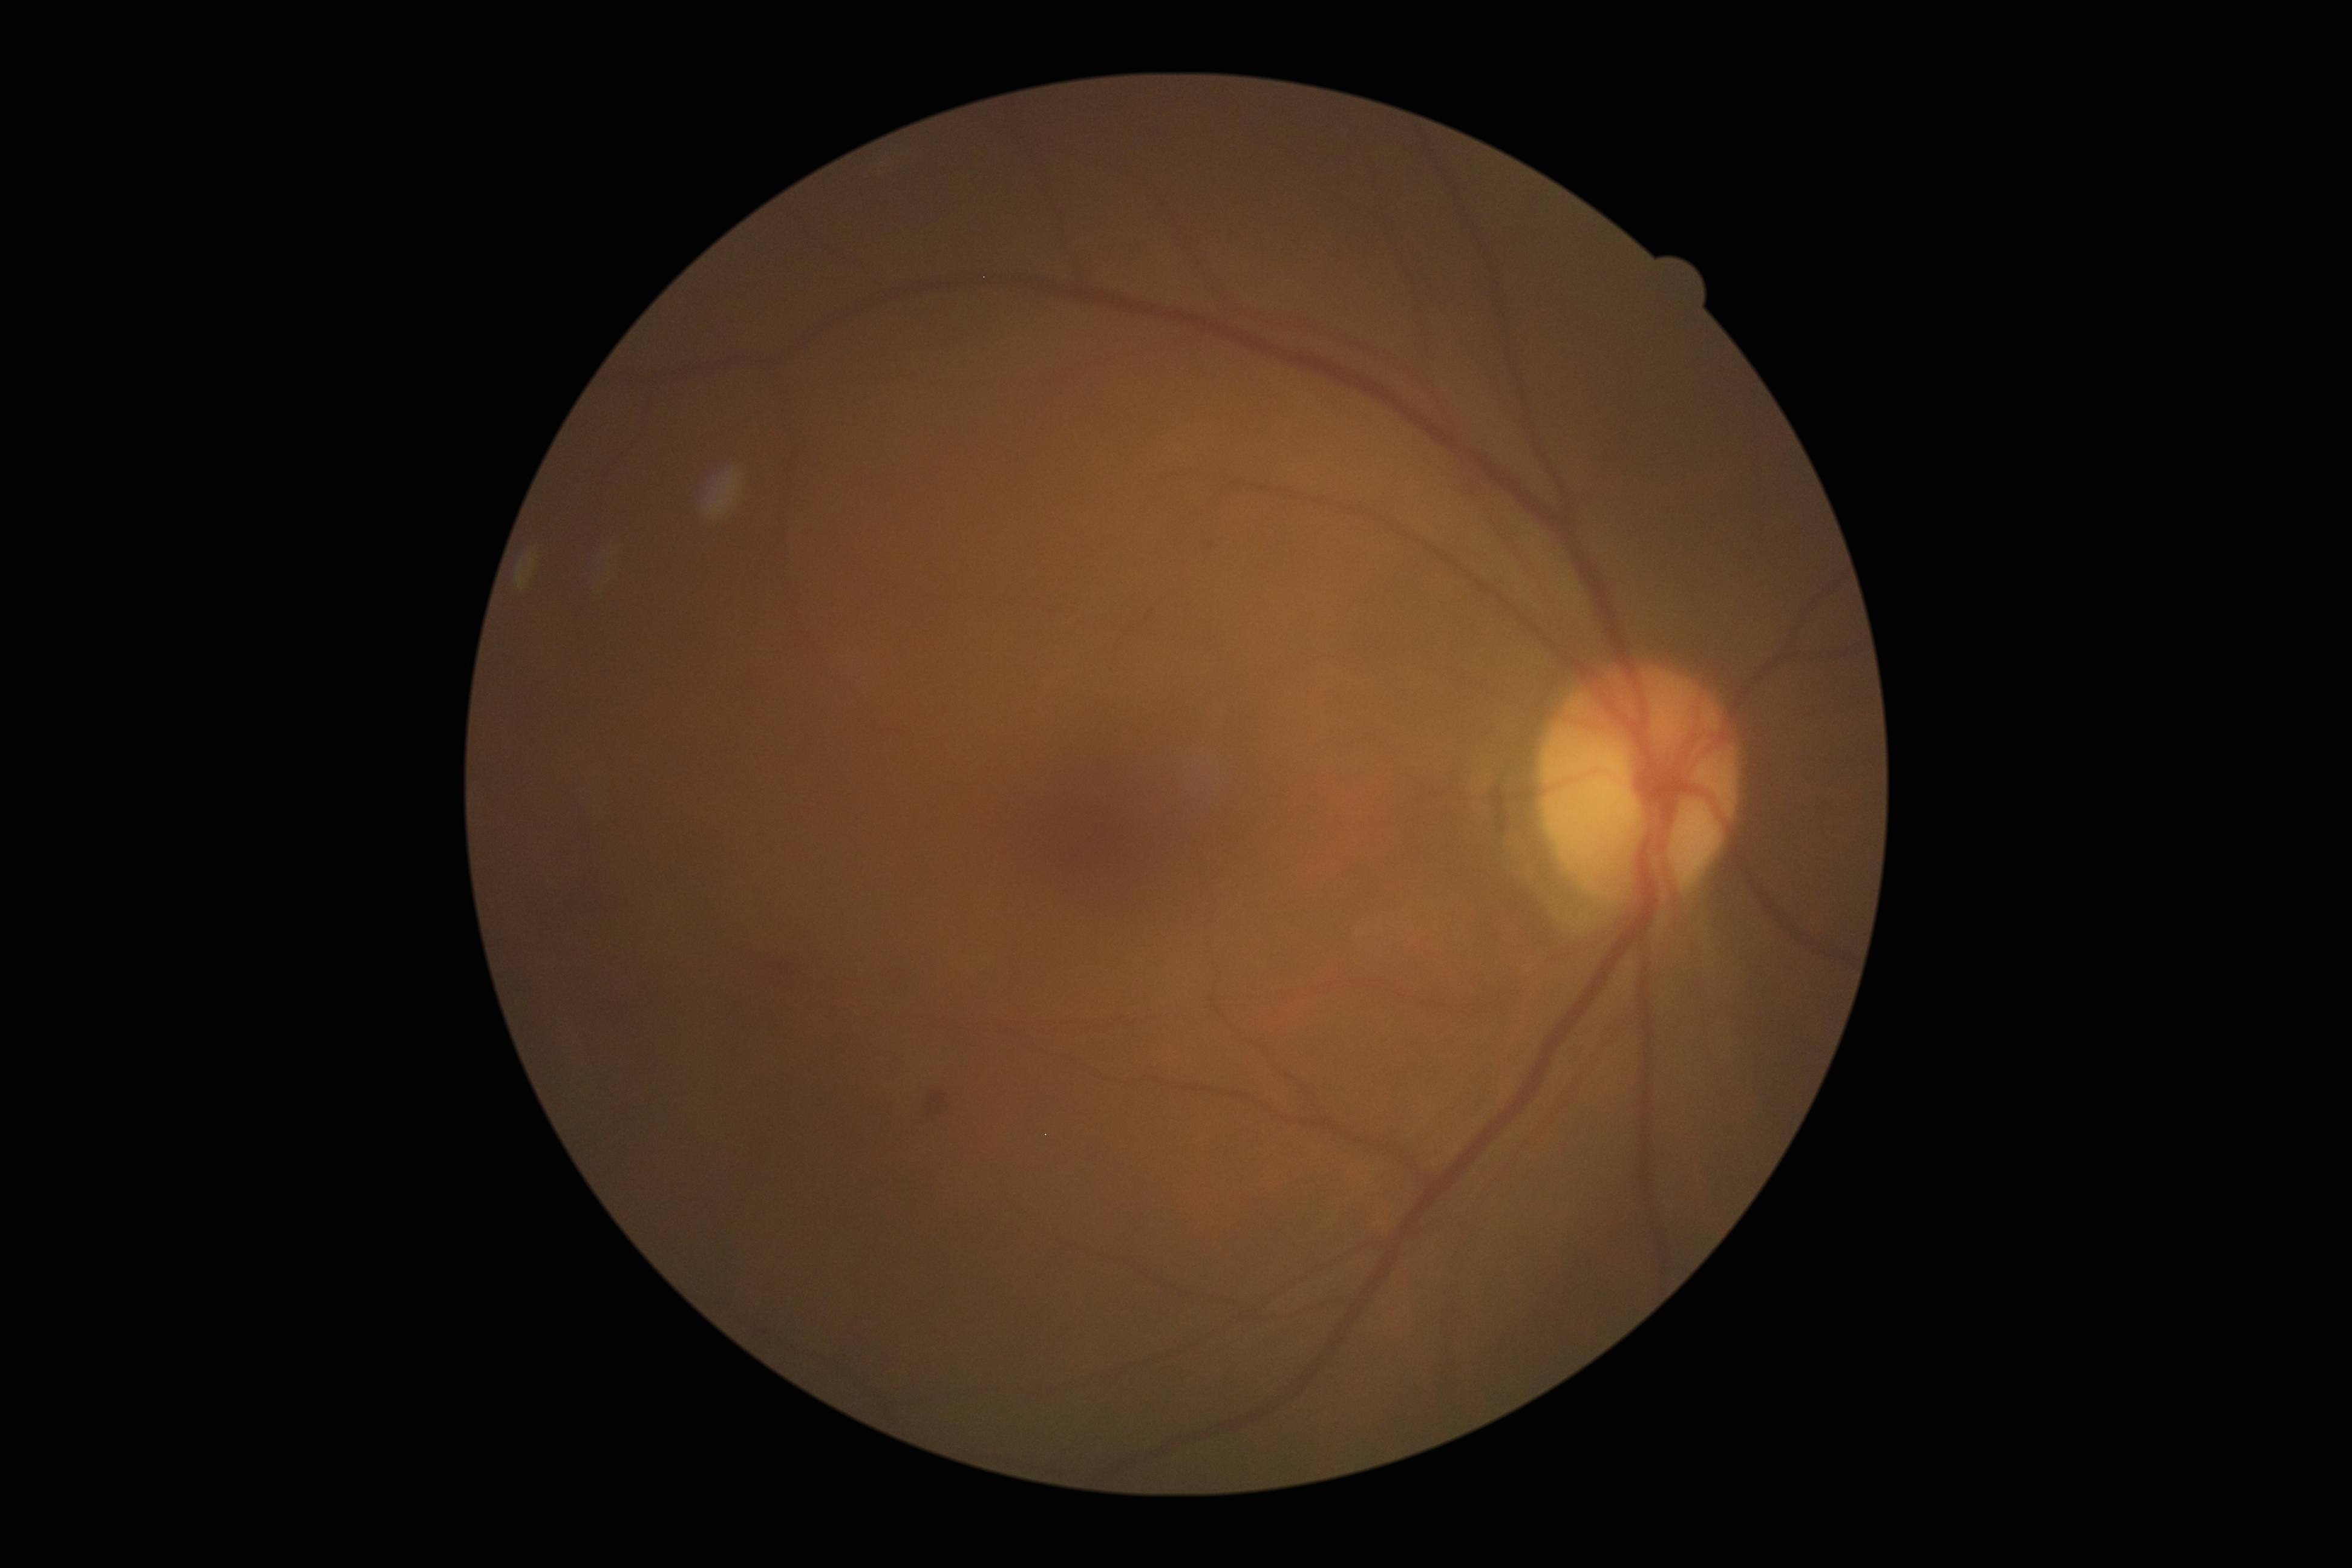

diabetic retinopathy (DR): 2/4 — more than just microaneurysms but less than severe NPDR.